Retinal fundus photograph; 2228x1652px; FOV: 50 degrees — 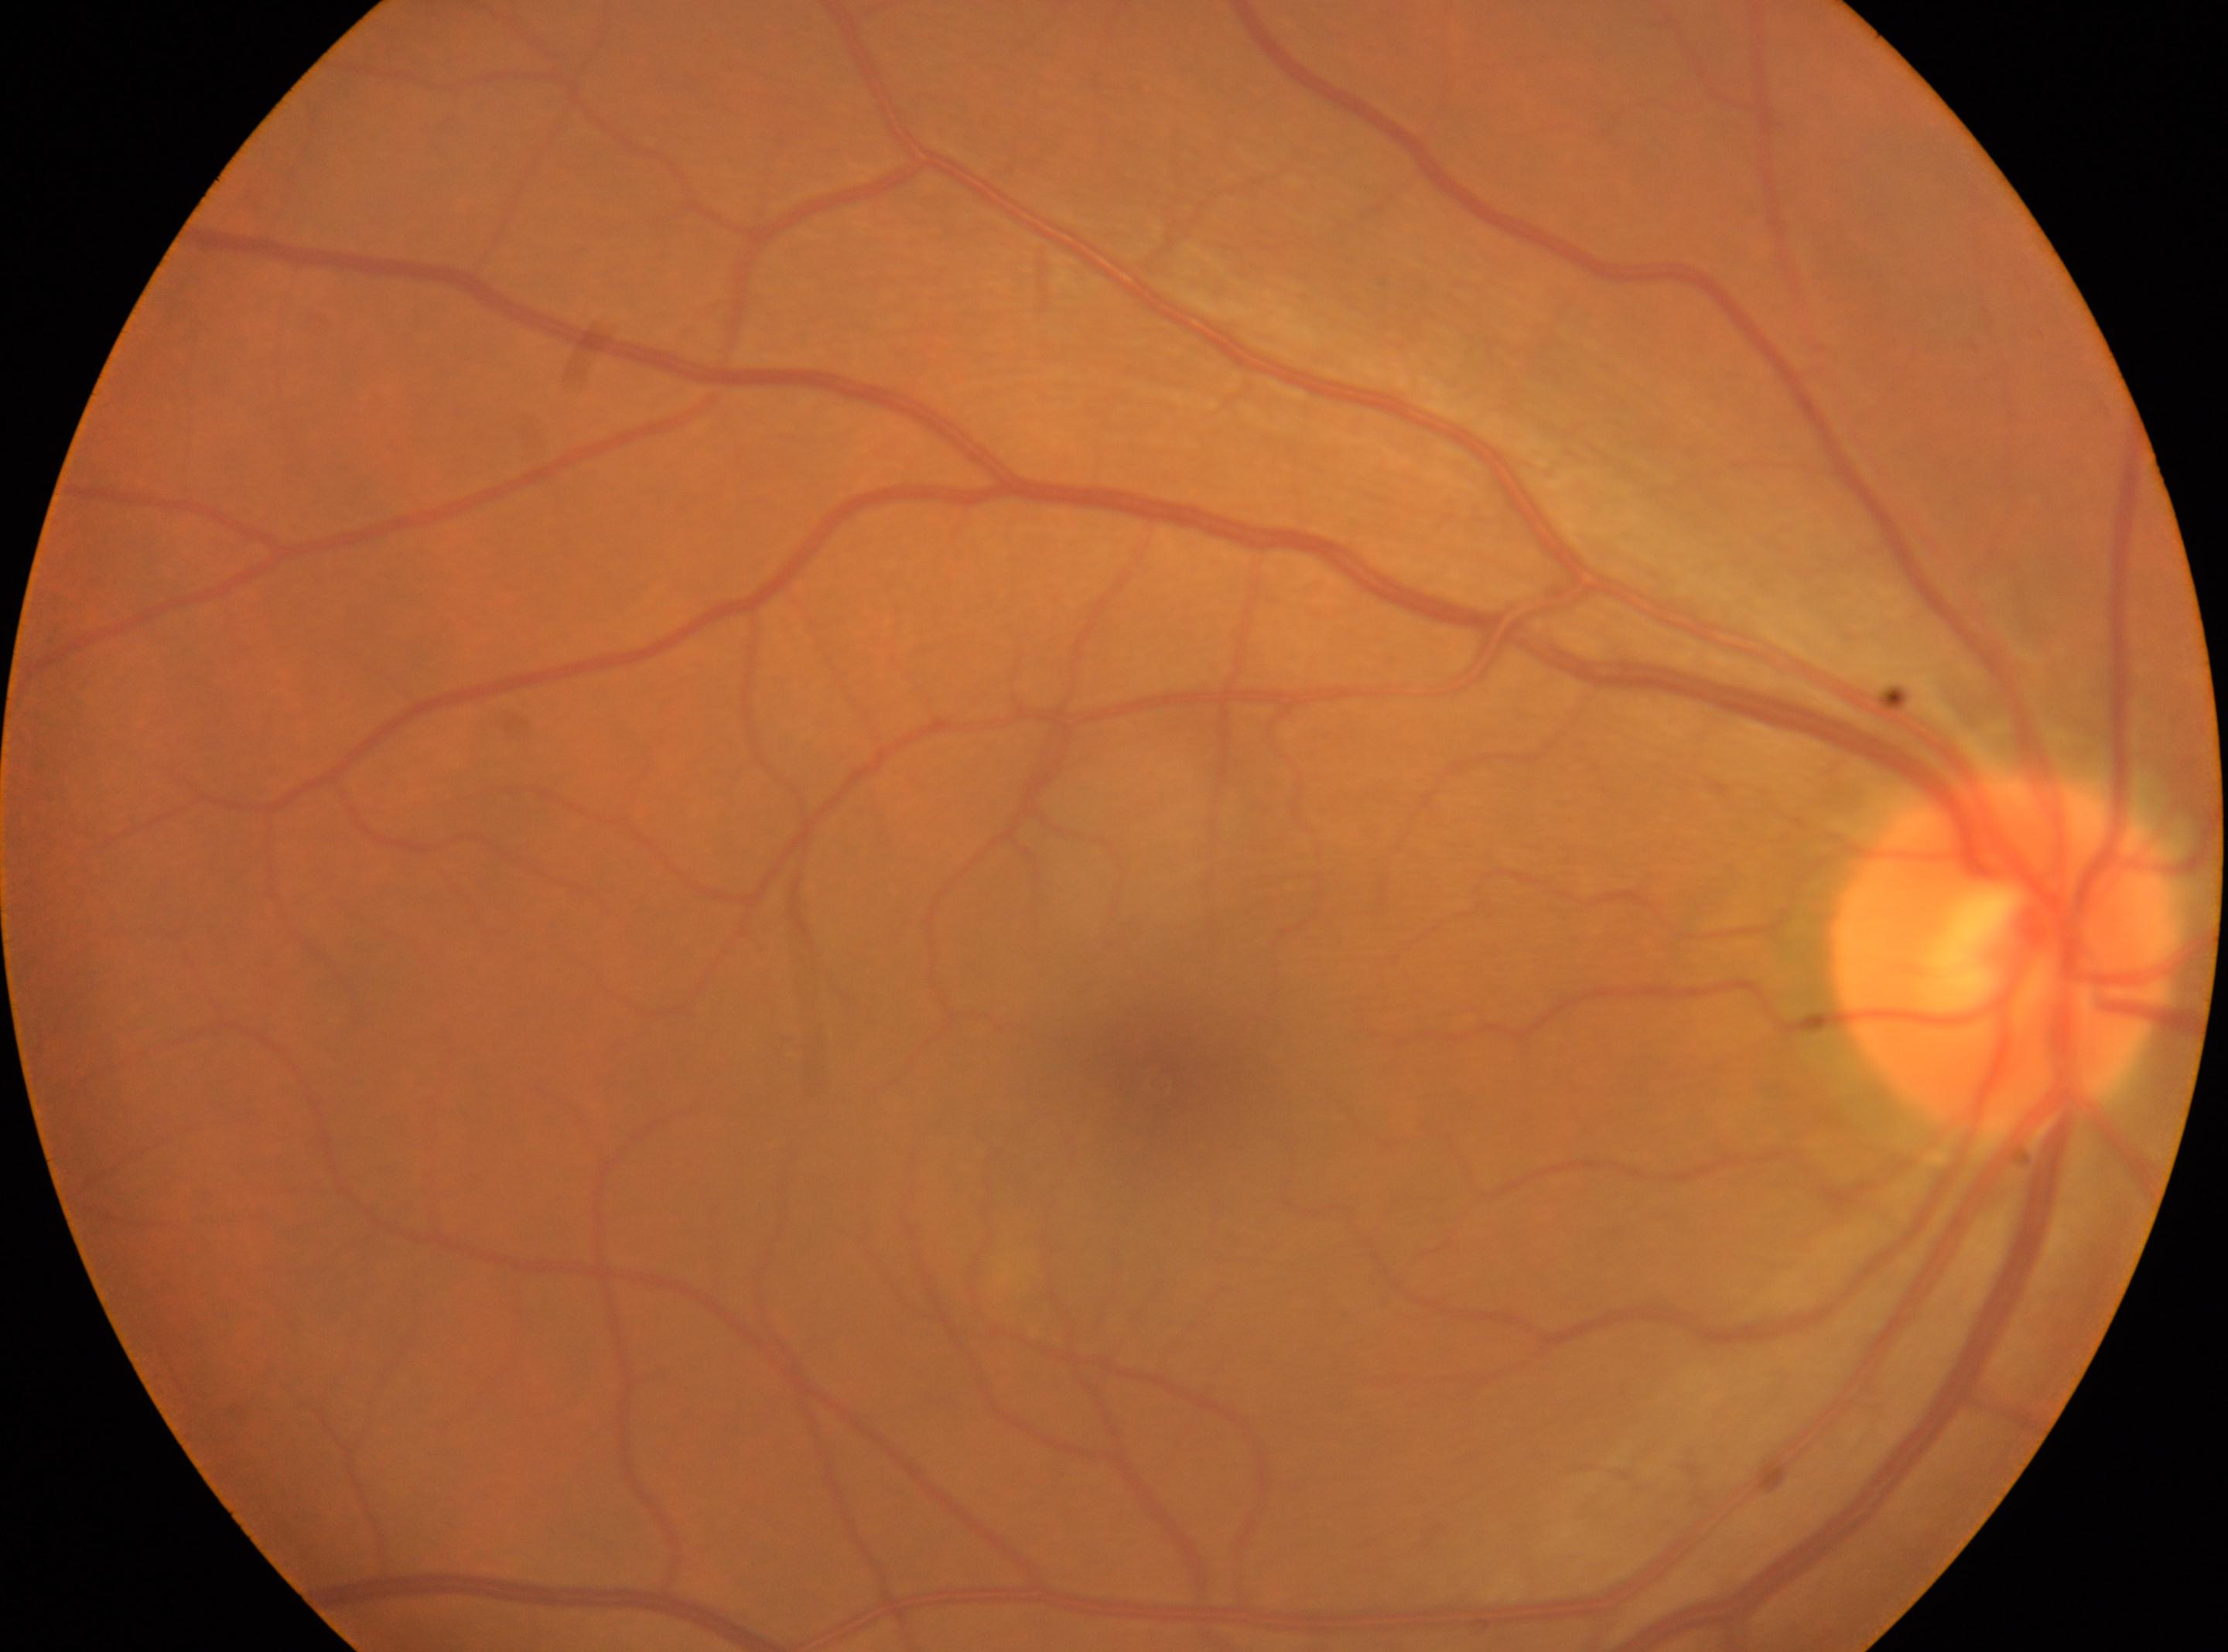
Q: Locate the fovea.
A: (x=1146, y=1077)
Q: Right or left eye?
A: right
Q: What is the DR grade?
A: grade 0 (no apparent retinopathy)
Q: Optic disc center?
A: (x=2001, y=957)